Image size 2352x1568 — 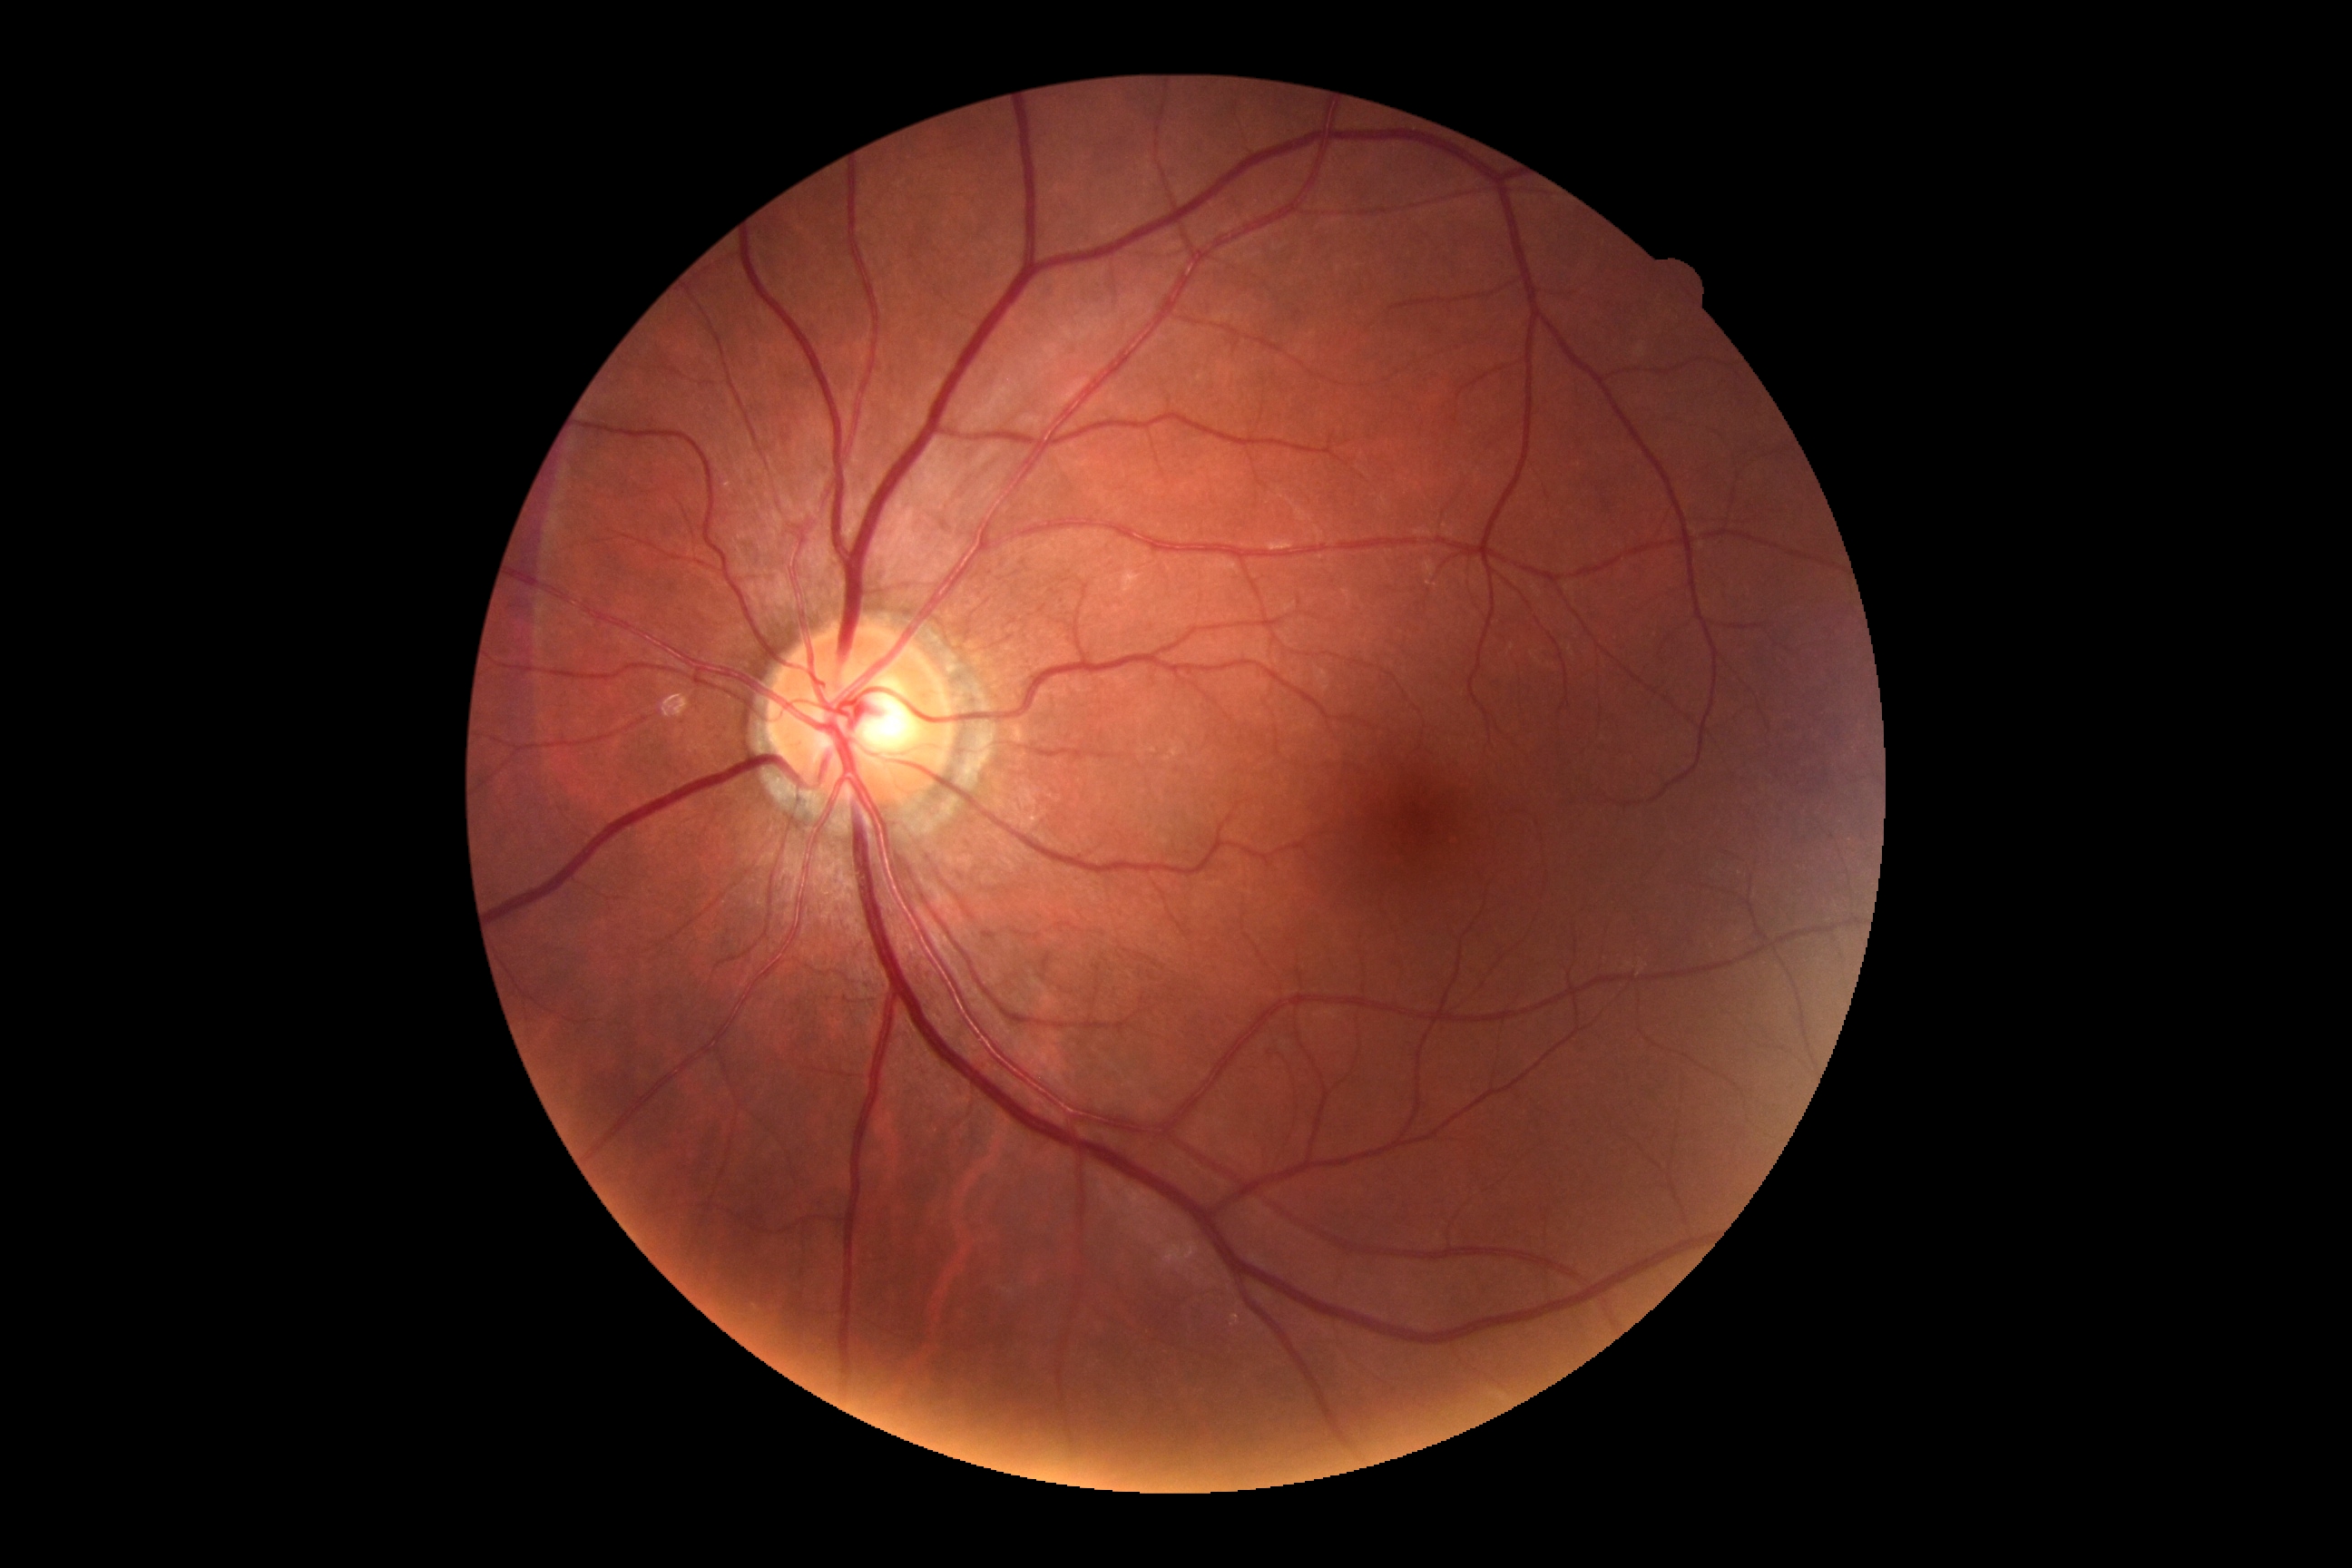 Diabetic retinopathy grade: no apparent retinopathy (0).
No signs of diabetic retinopathy.